Modified Davis grading
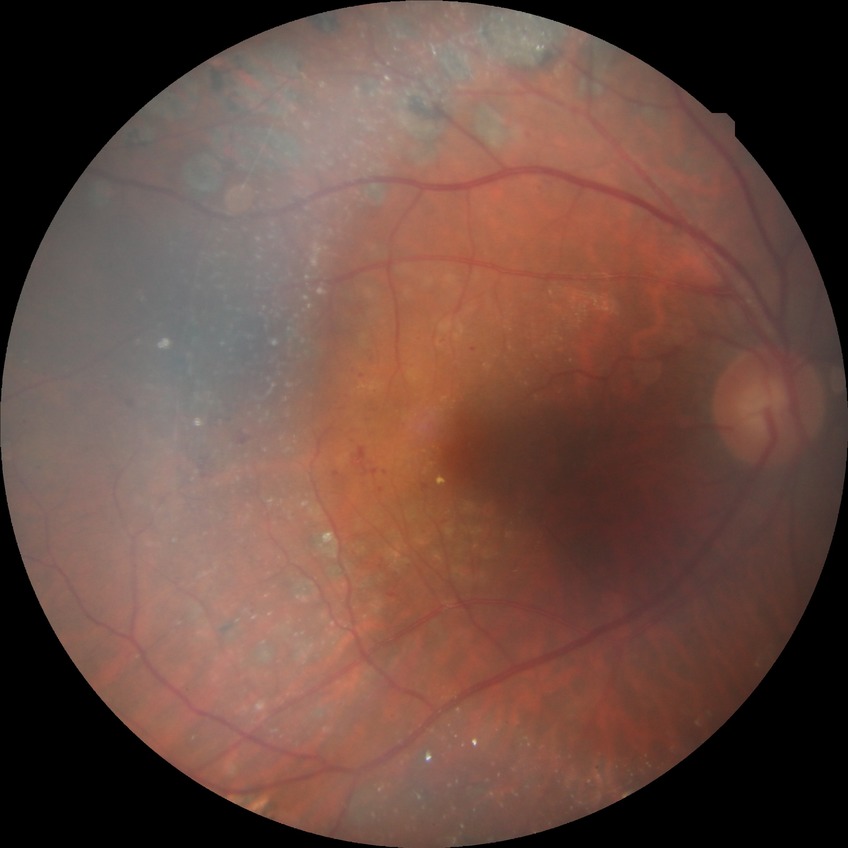

Diabetic retinopathy (DR) is PDR (proliferative diabetic retinopathy).